Wide-field retinal mosaic image; 200-degree field of view:
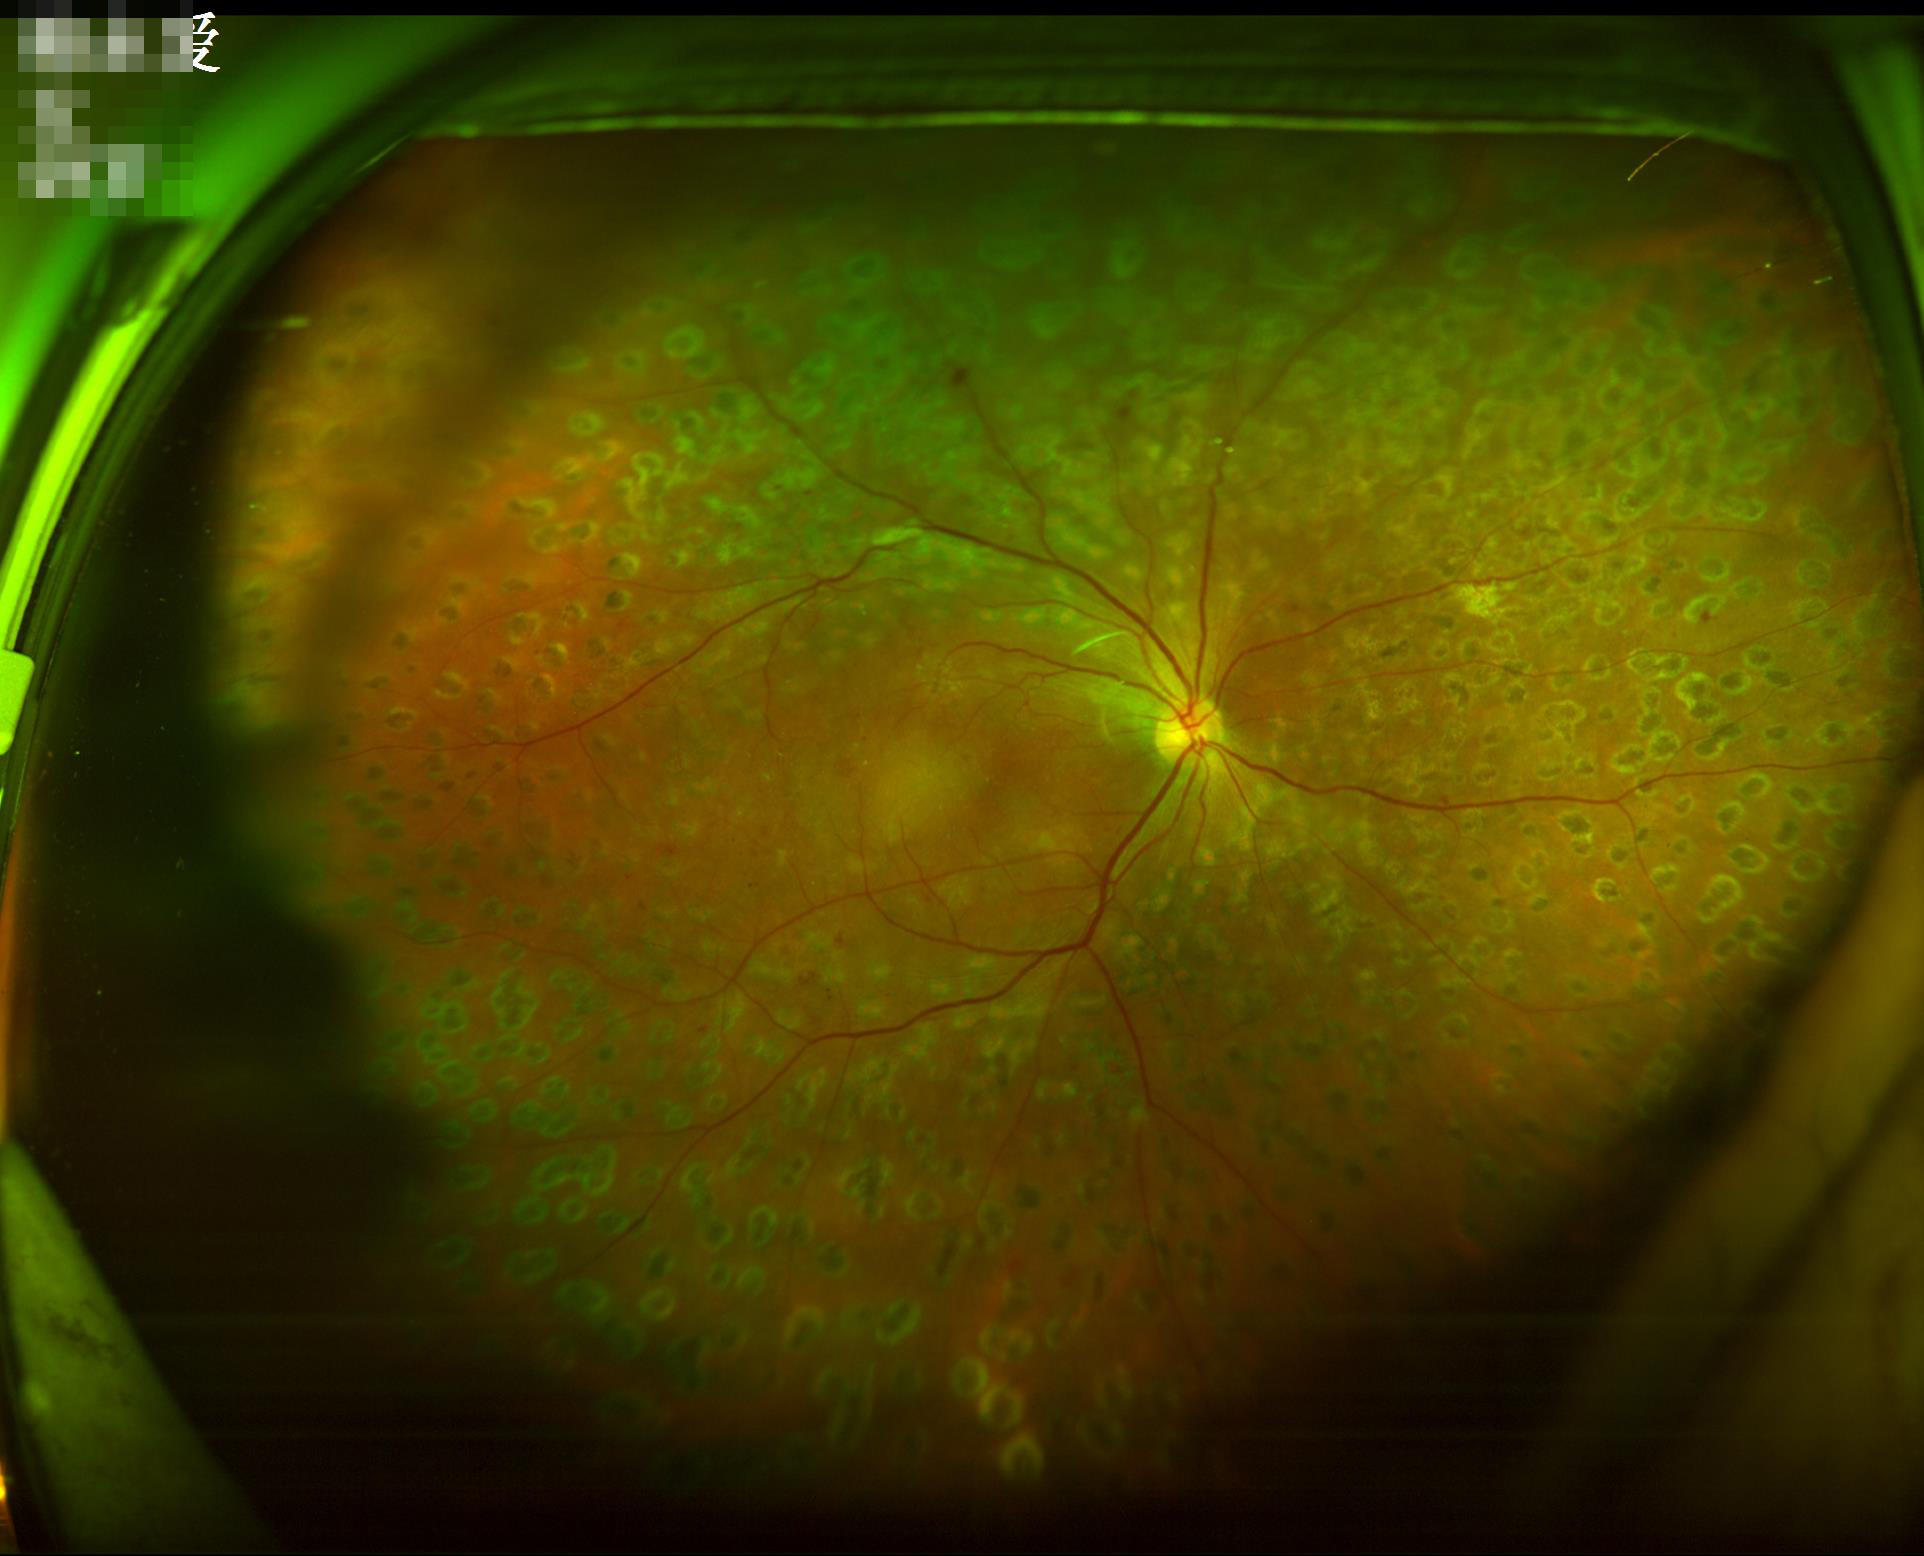
{"contrast": "satisfactory", "illumination": "even", "overall_quality": "adequate"}